45-degree field of view · fundus photo
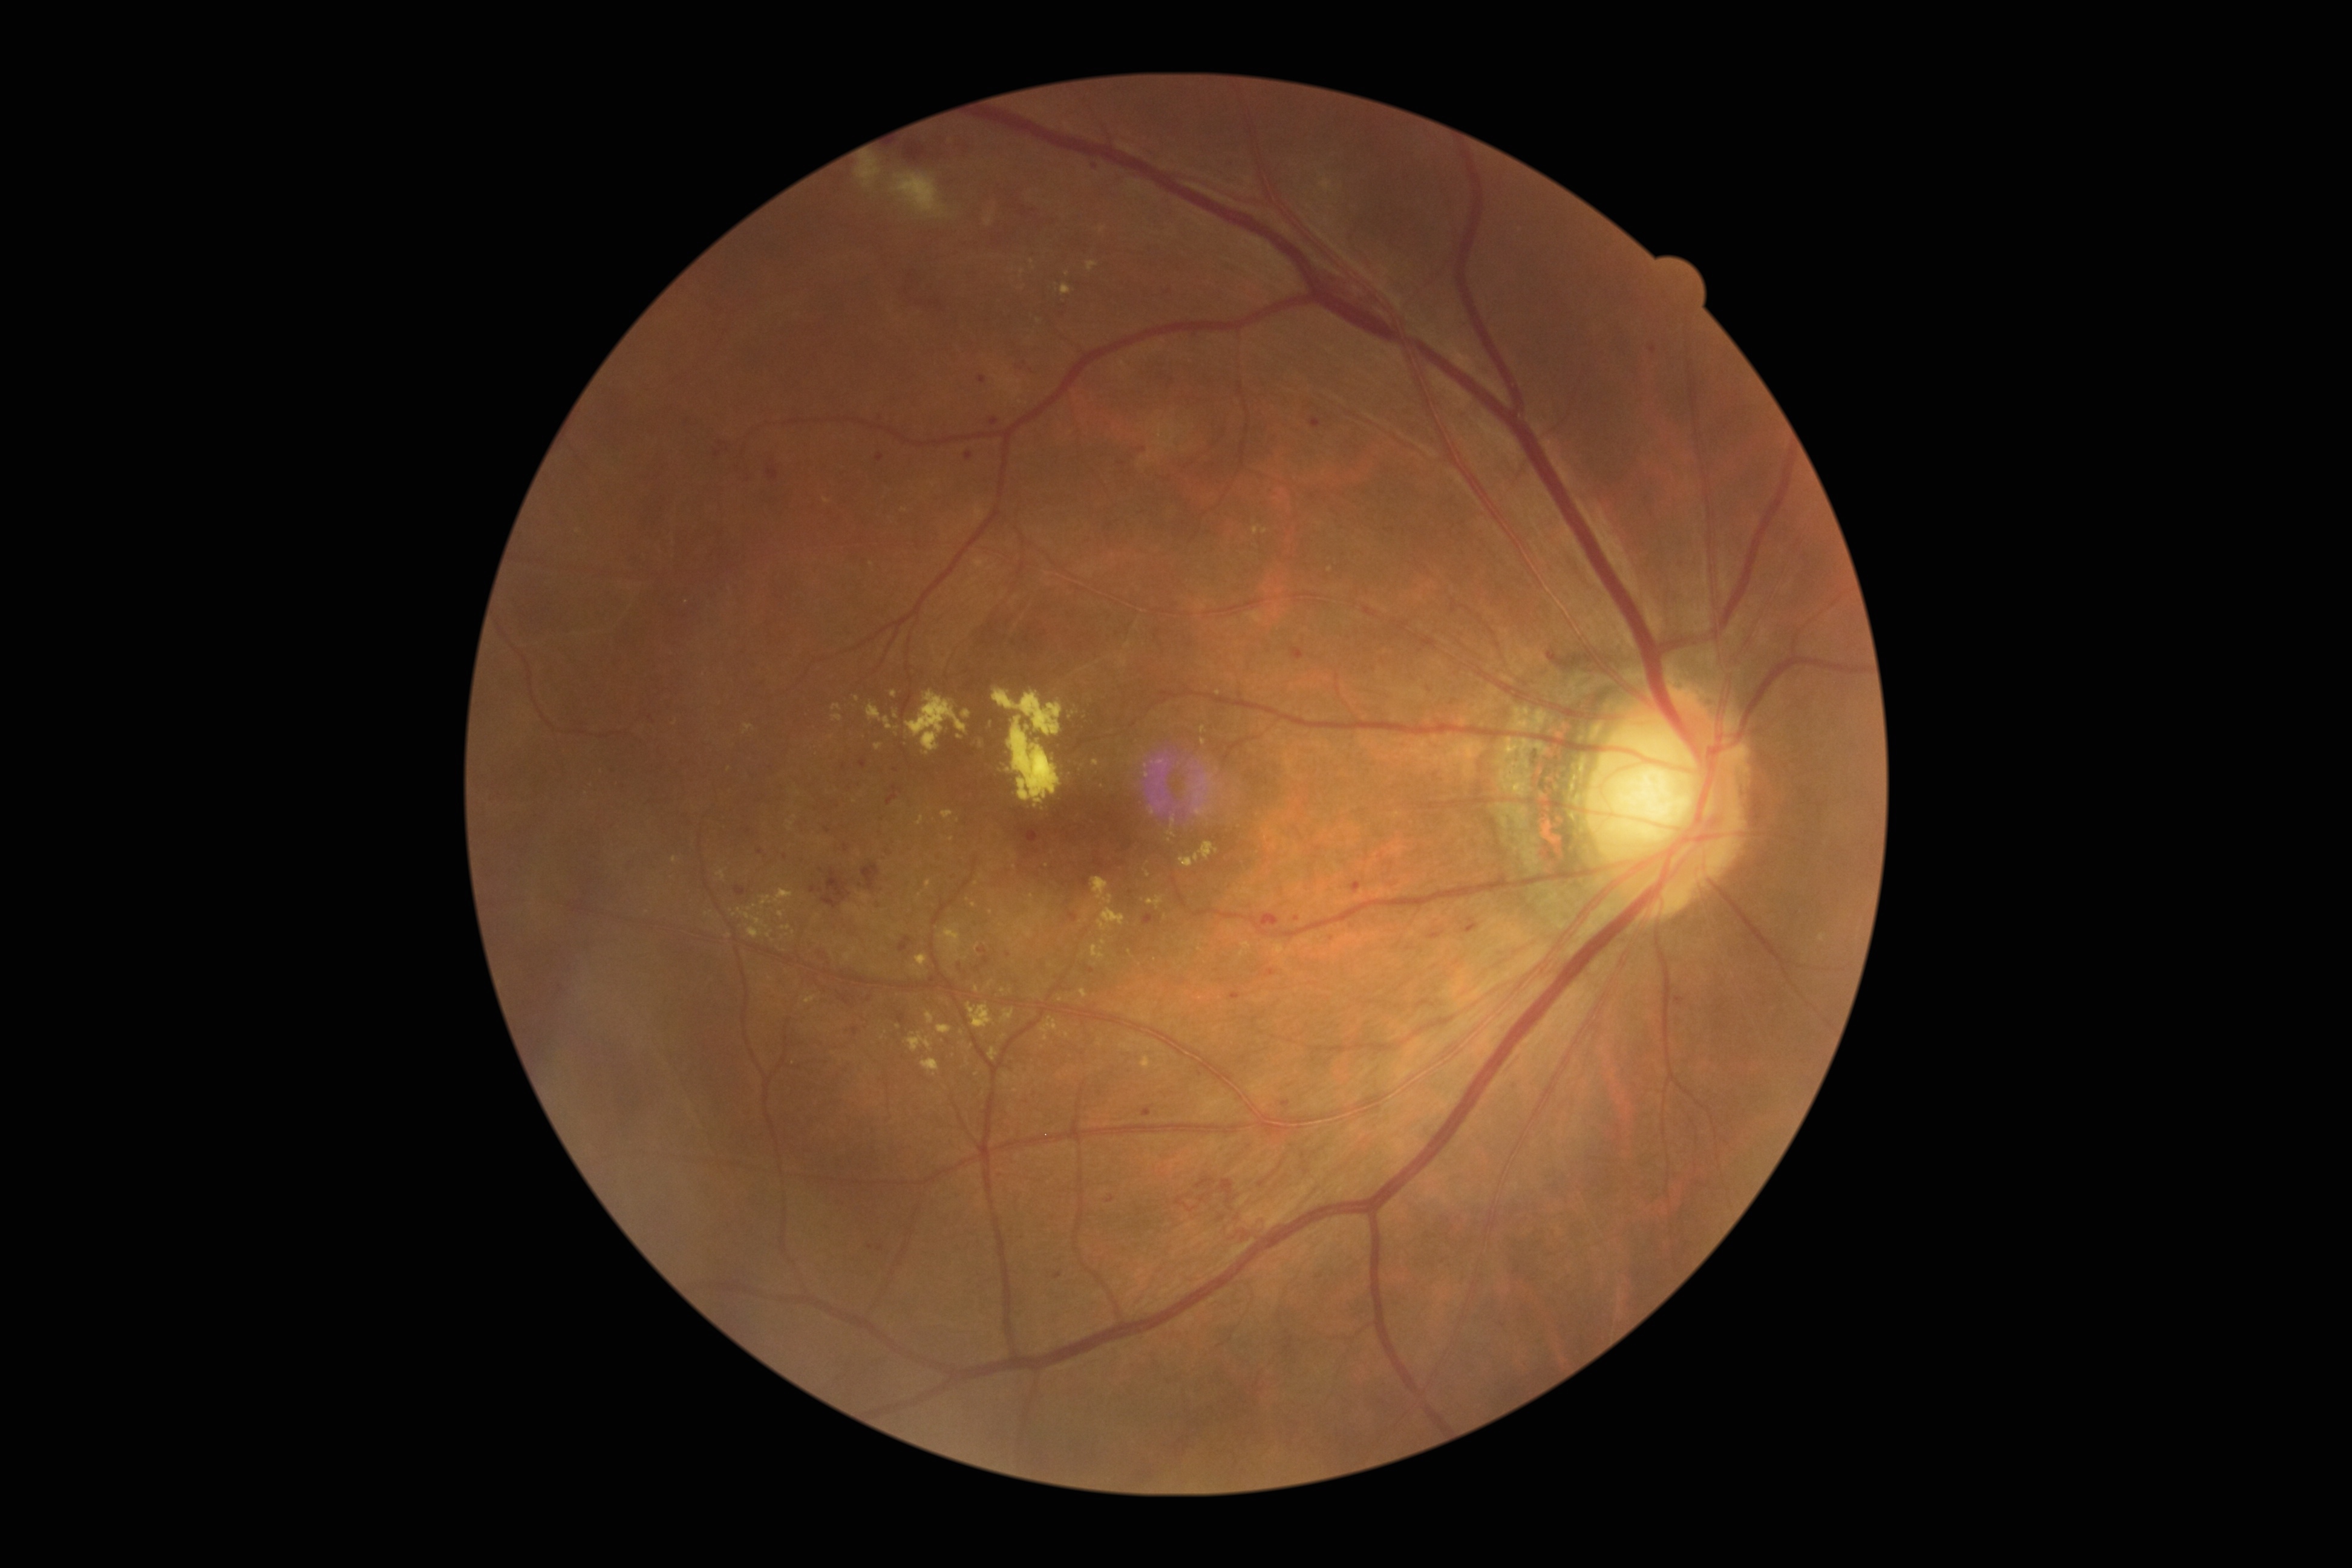

Diabetic retinopathy severity is 3.